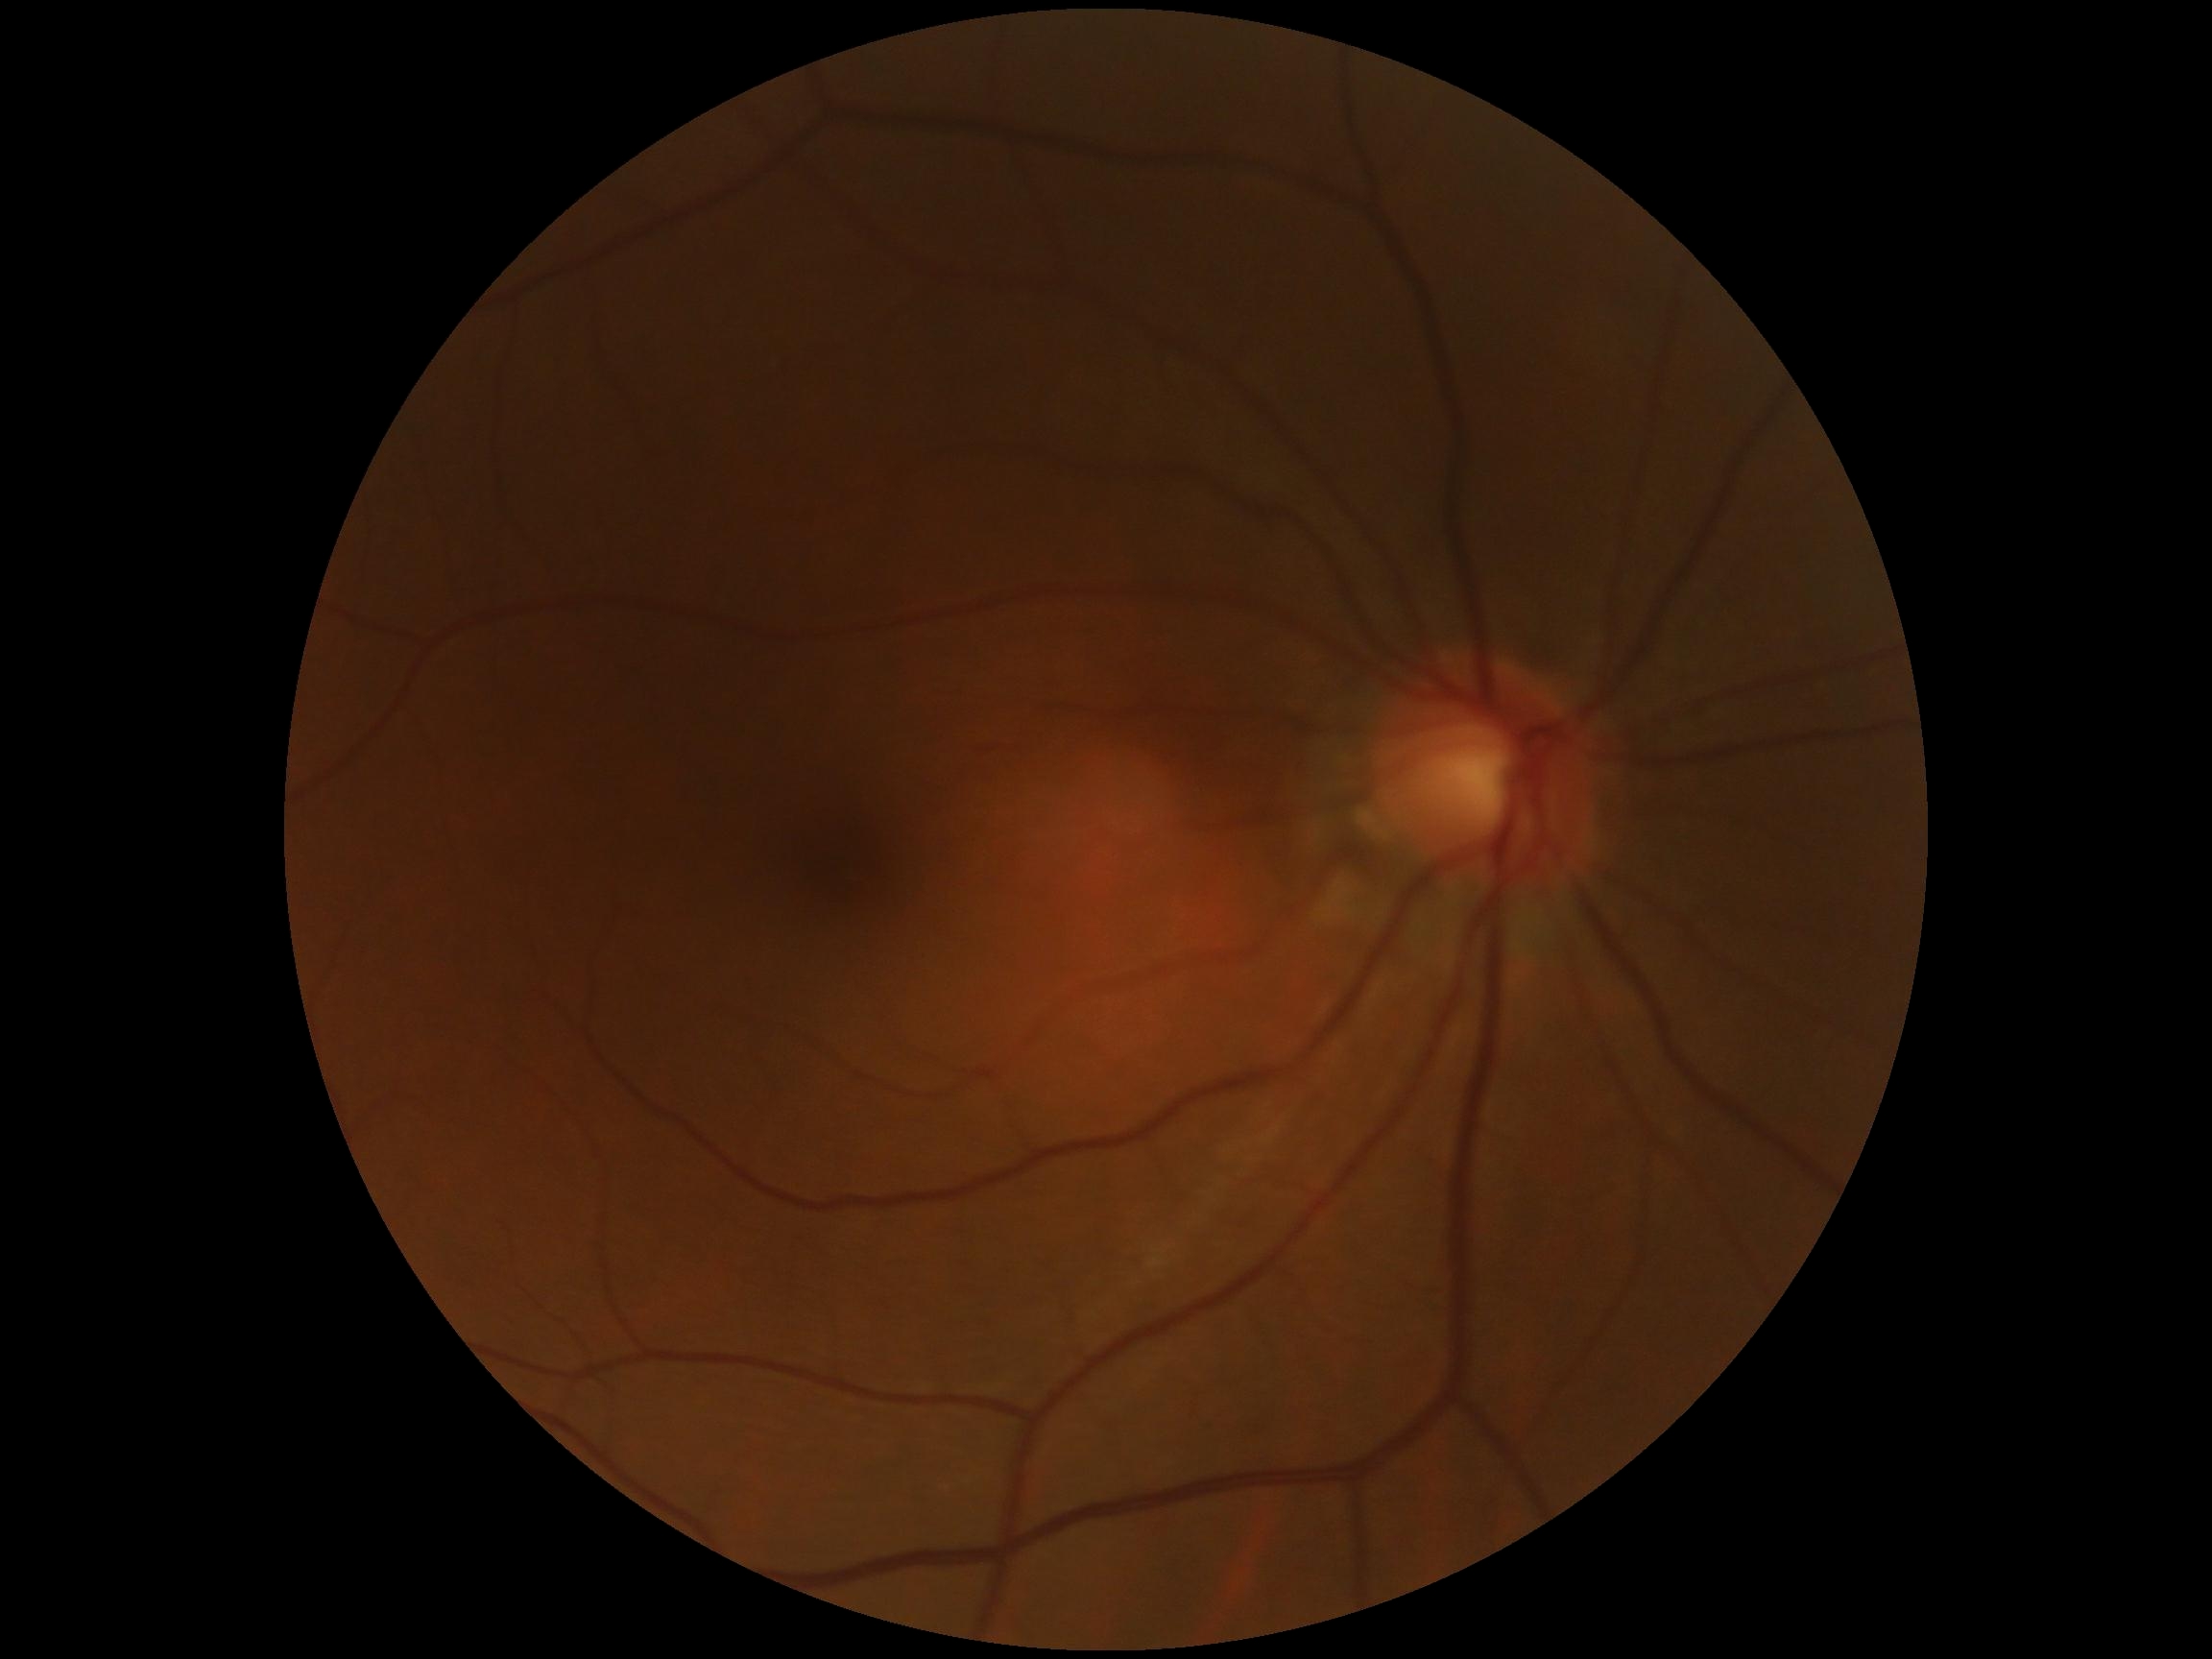 DR stage = grade 0 (no apparent retinopathy).